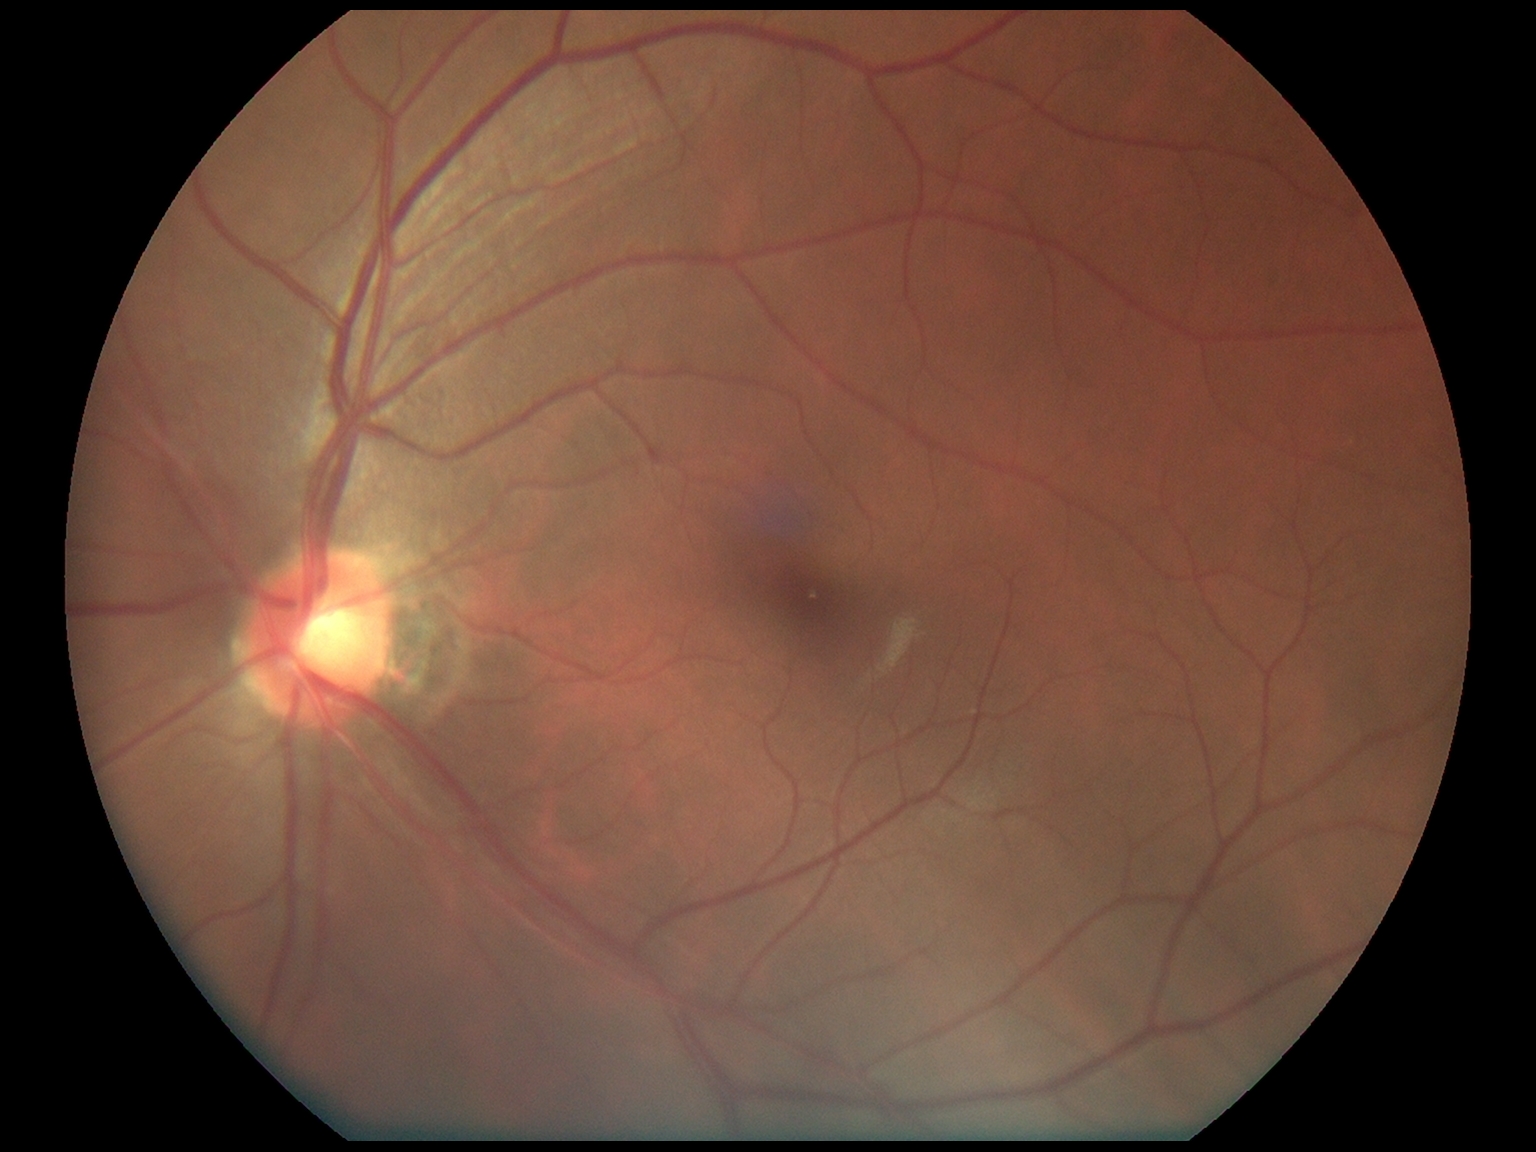

No signs of diabetic retinopathy.
DR severity is grade 0.